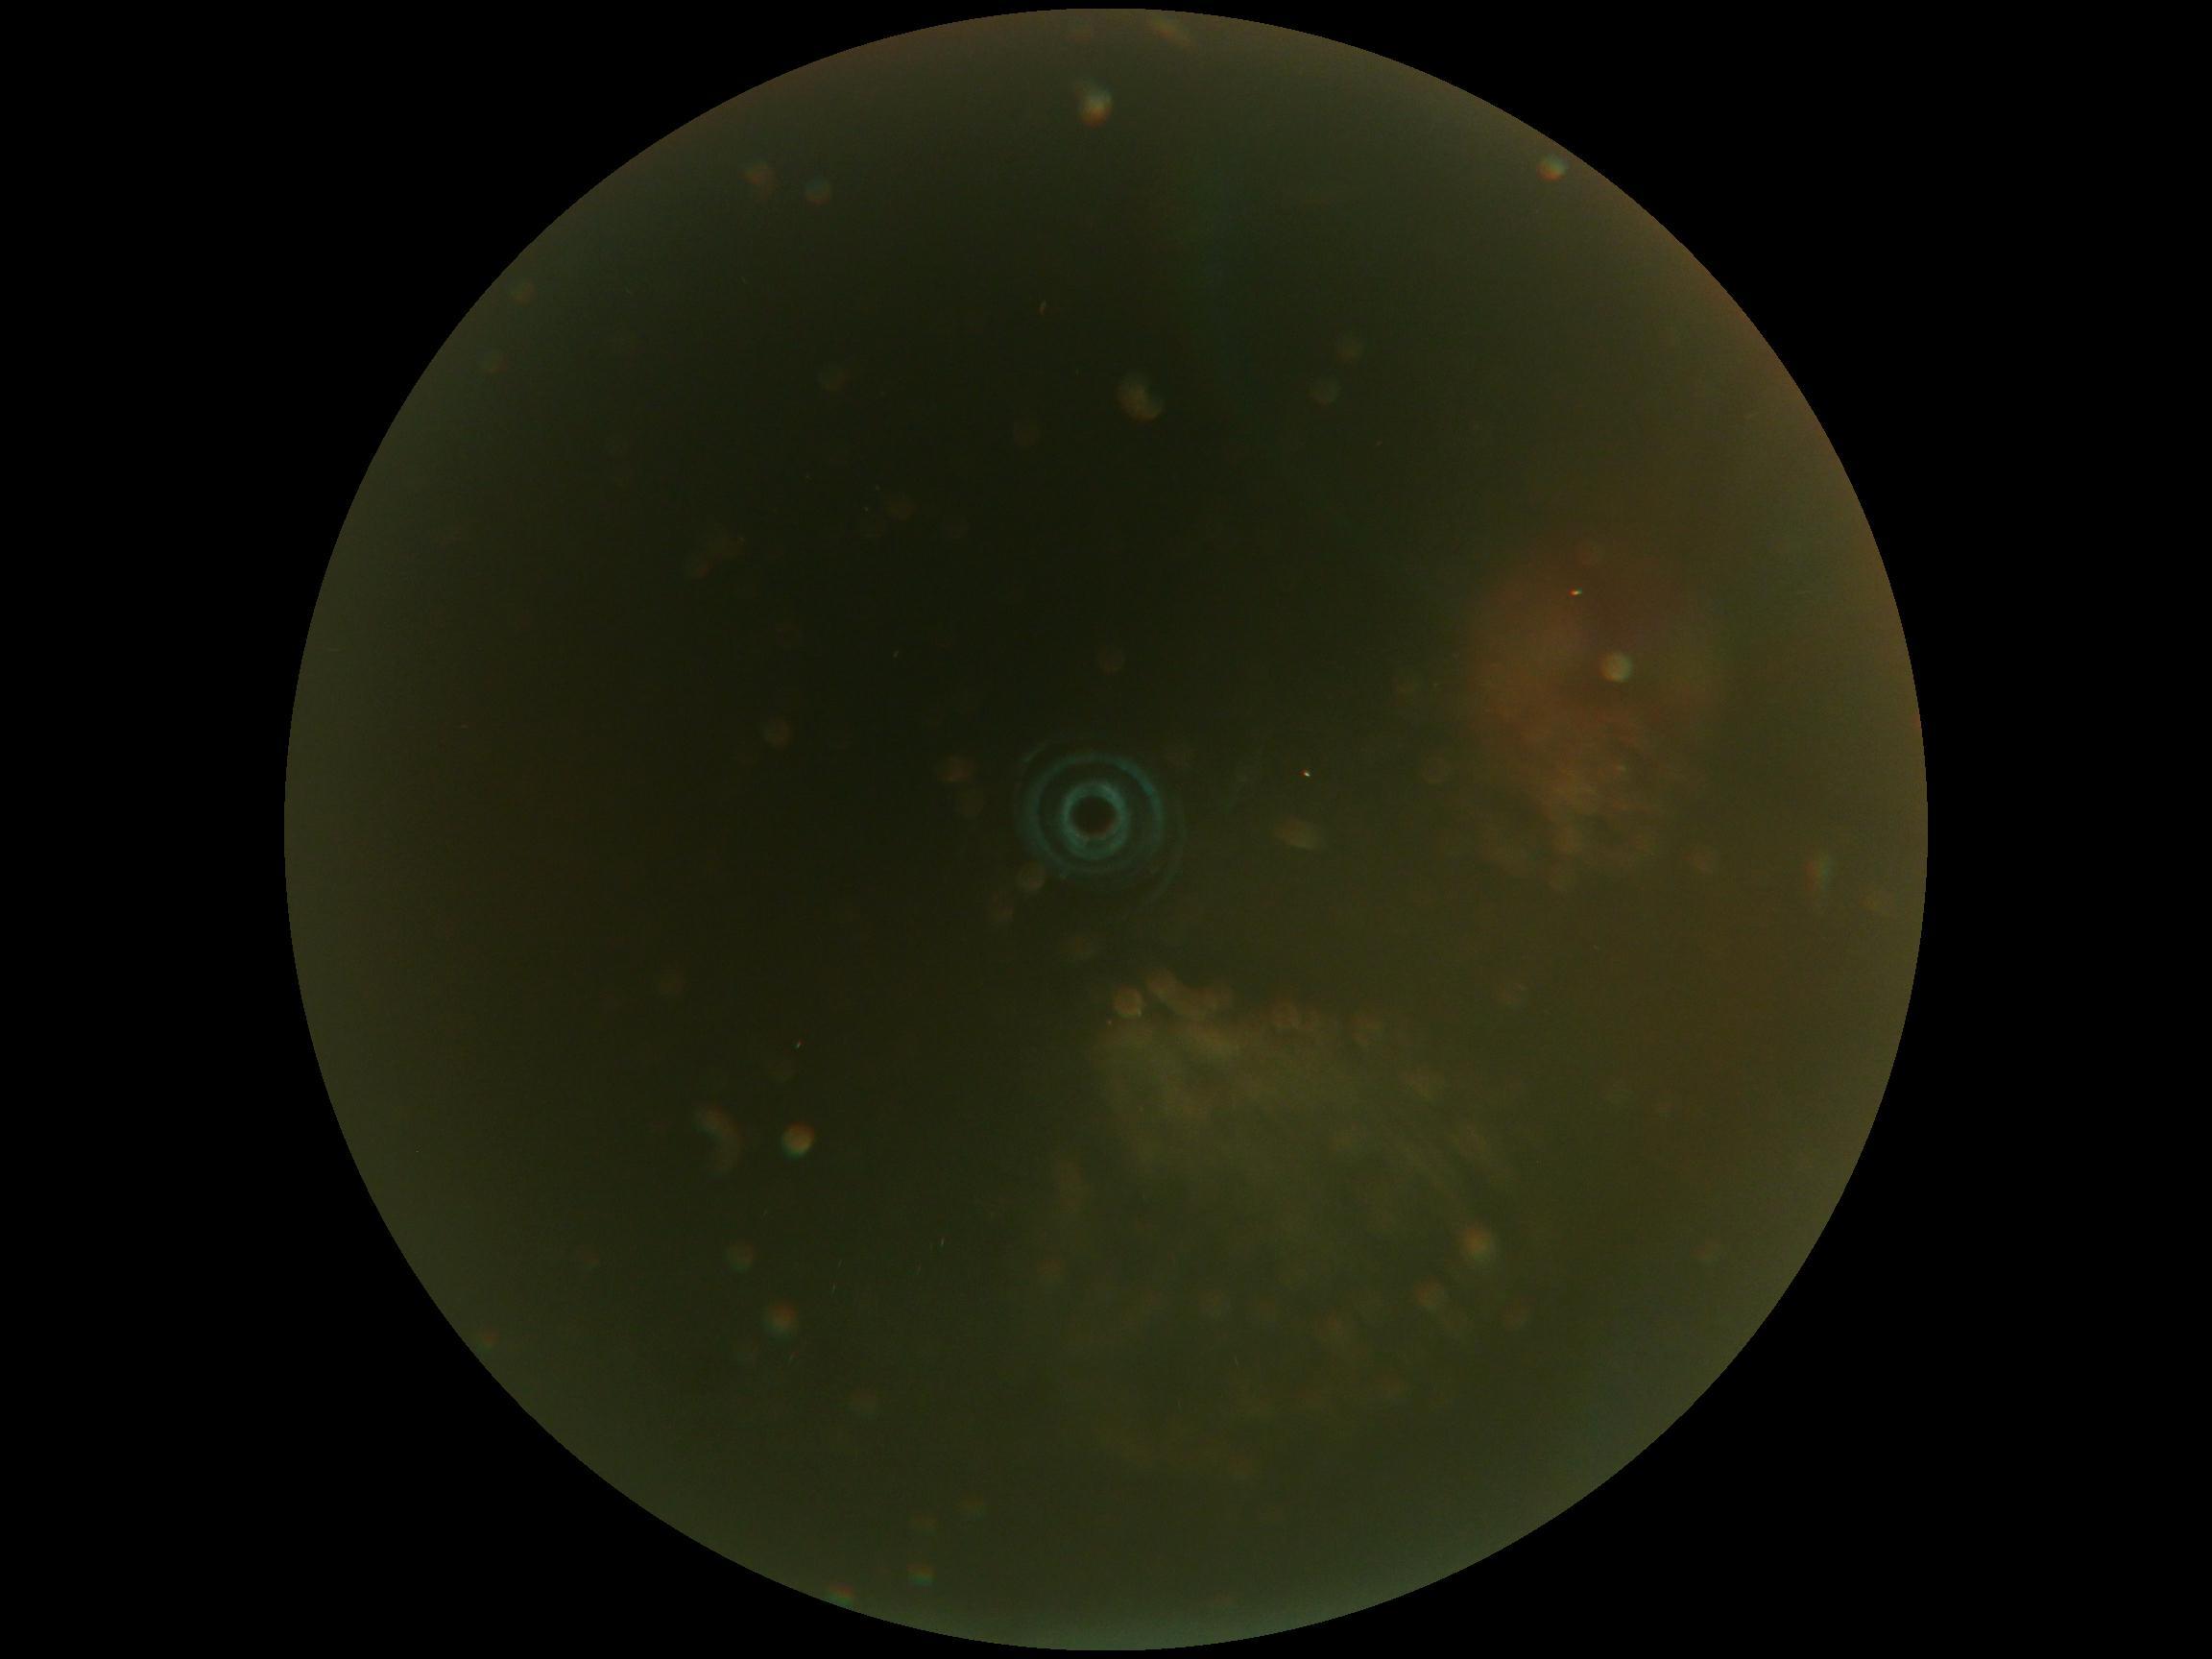 DR grade is ungradable due to poor image quality.